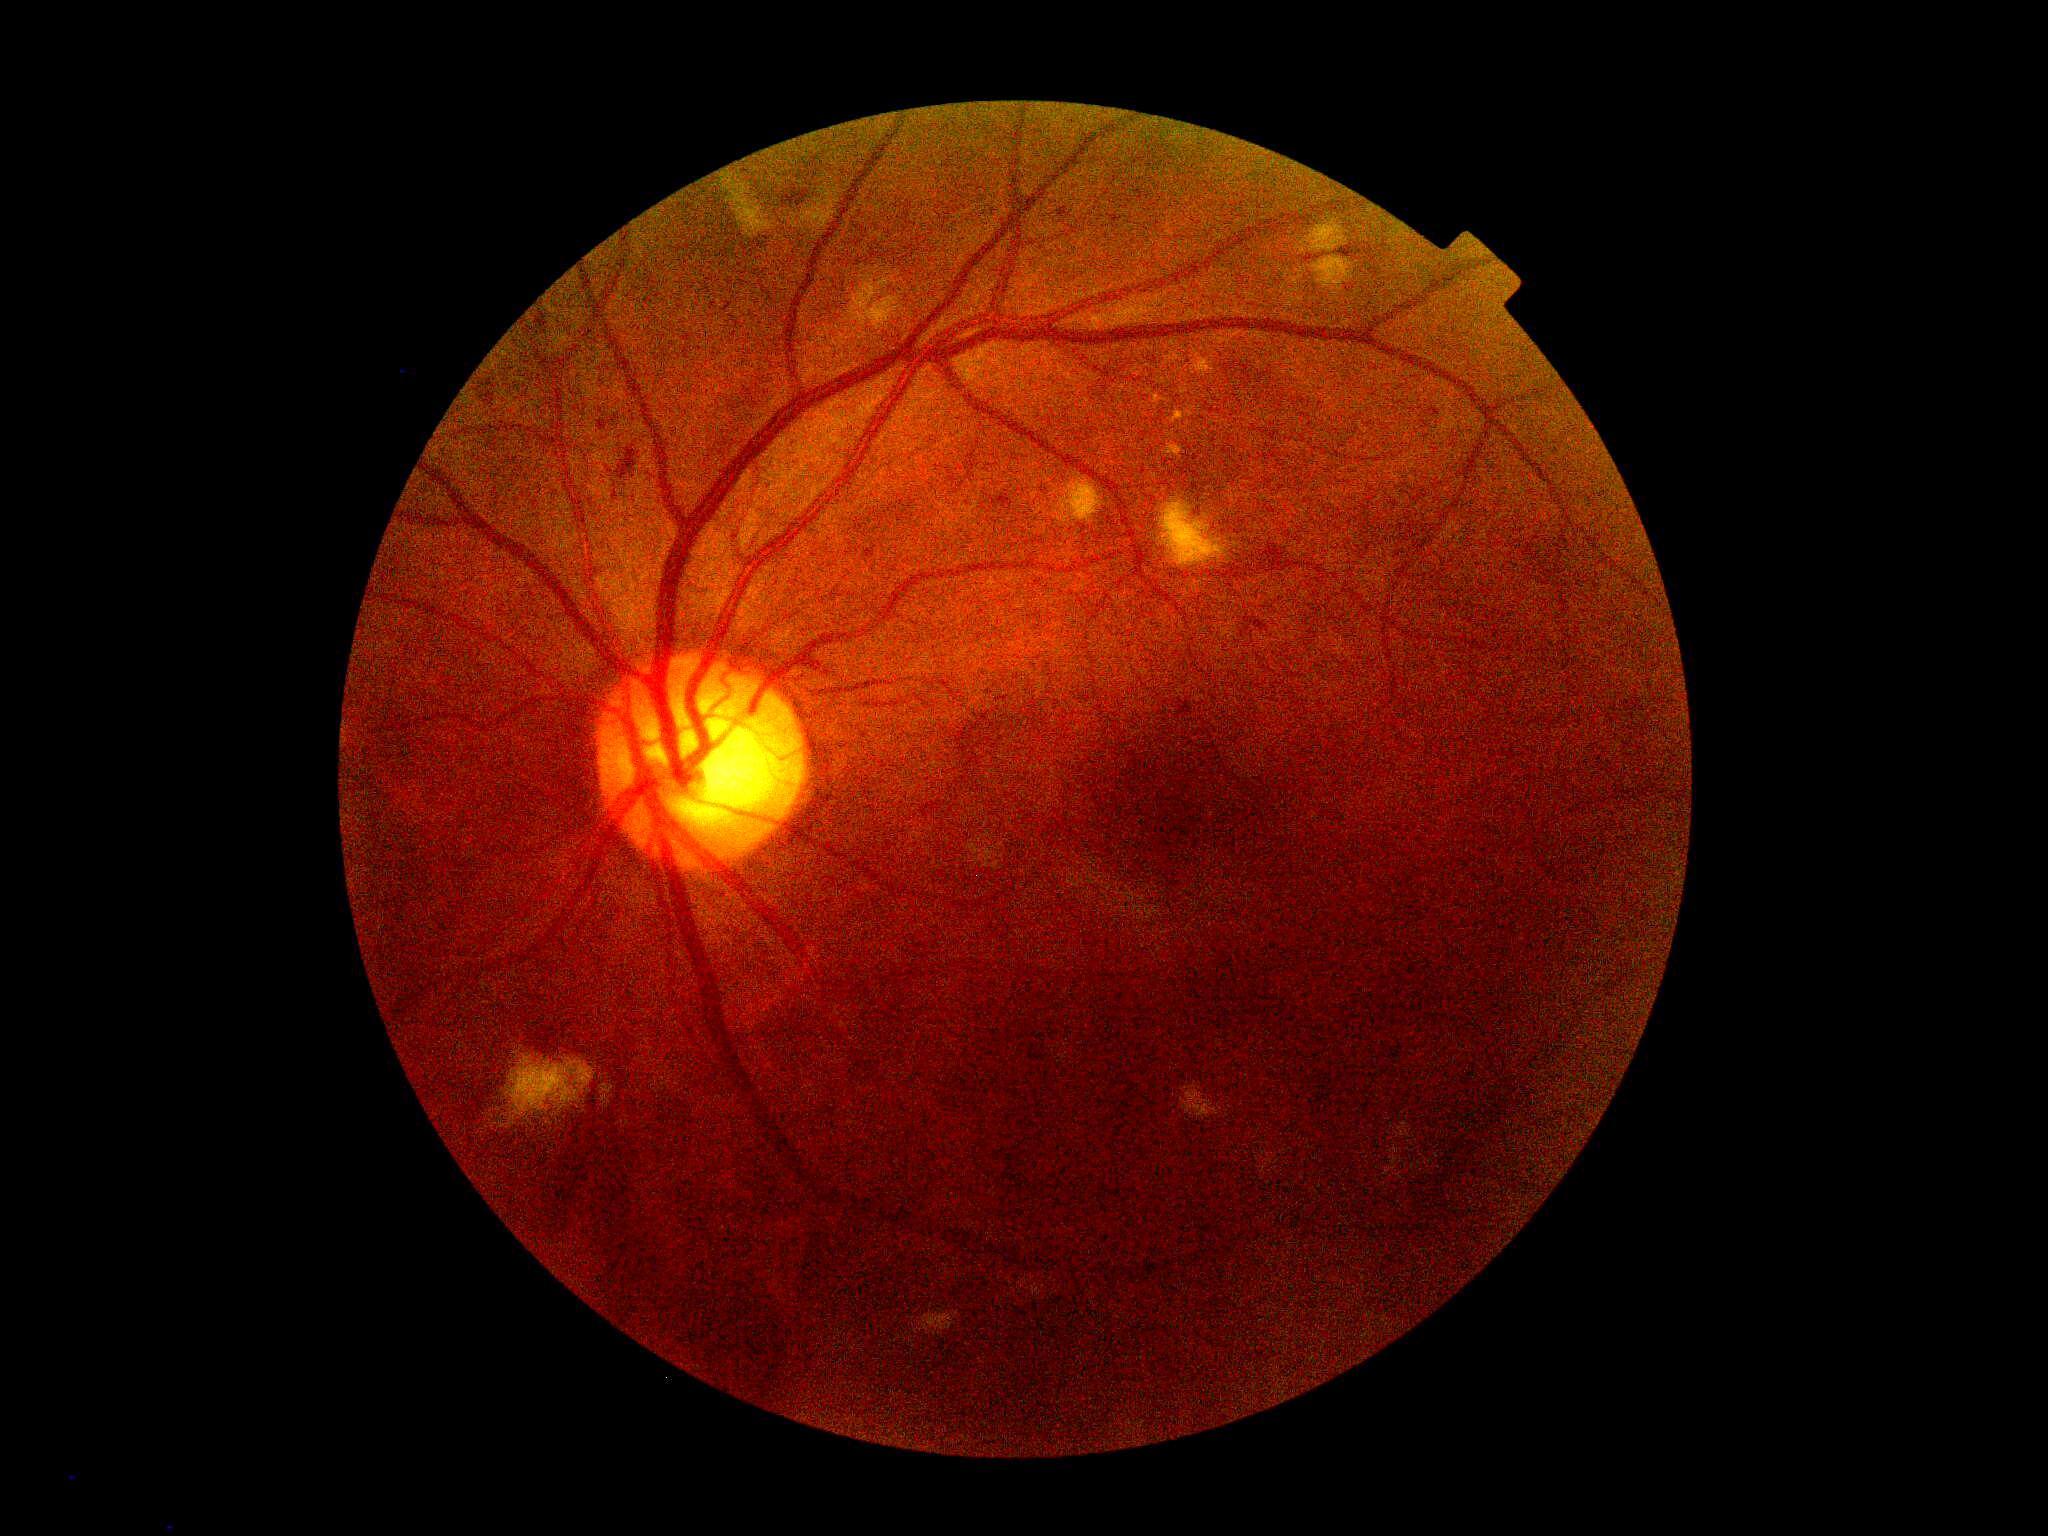

diabetic retinopathy (DR) = moderate non-proliferative diabetic retinopathy (grade 2) — more than just microaneurysms but less than severe NPDR
DR class = non-proliferative diabetic retinopathy